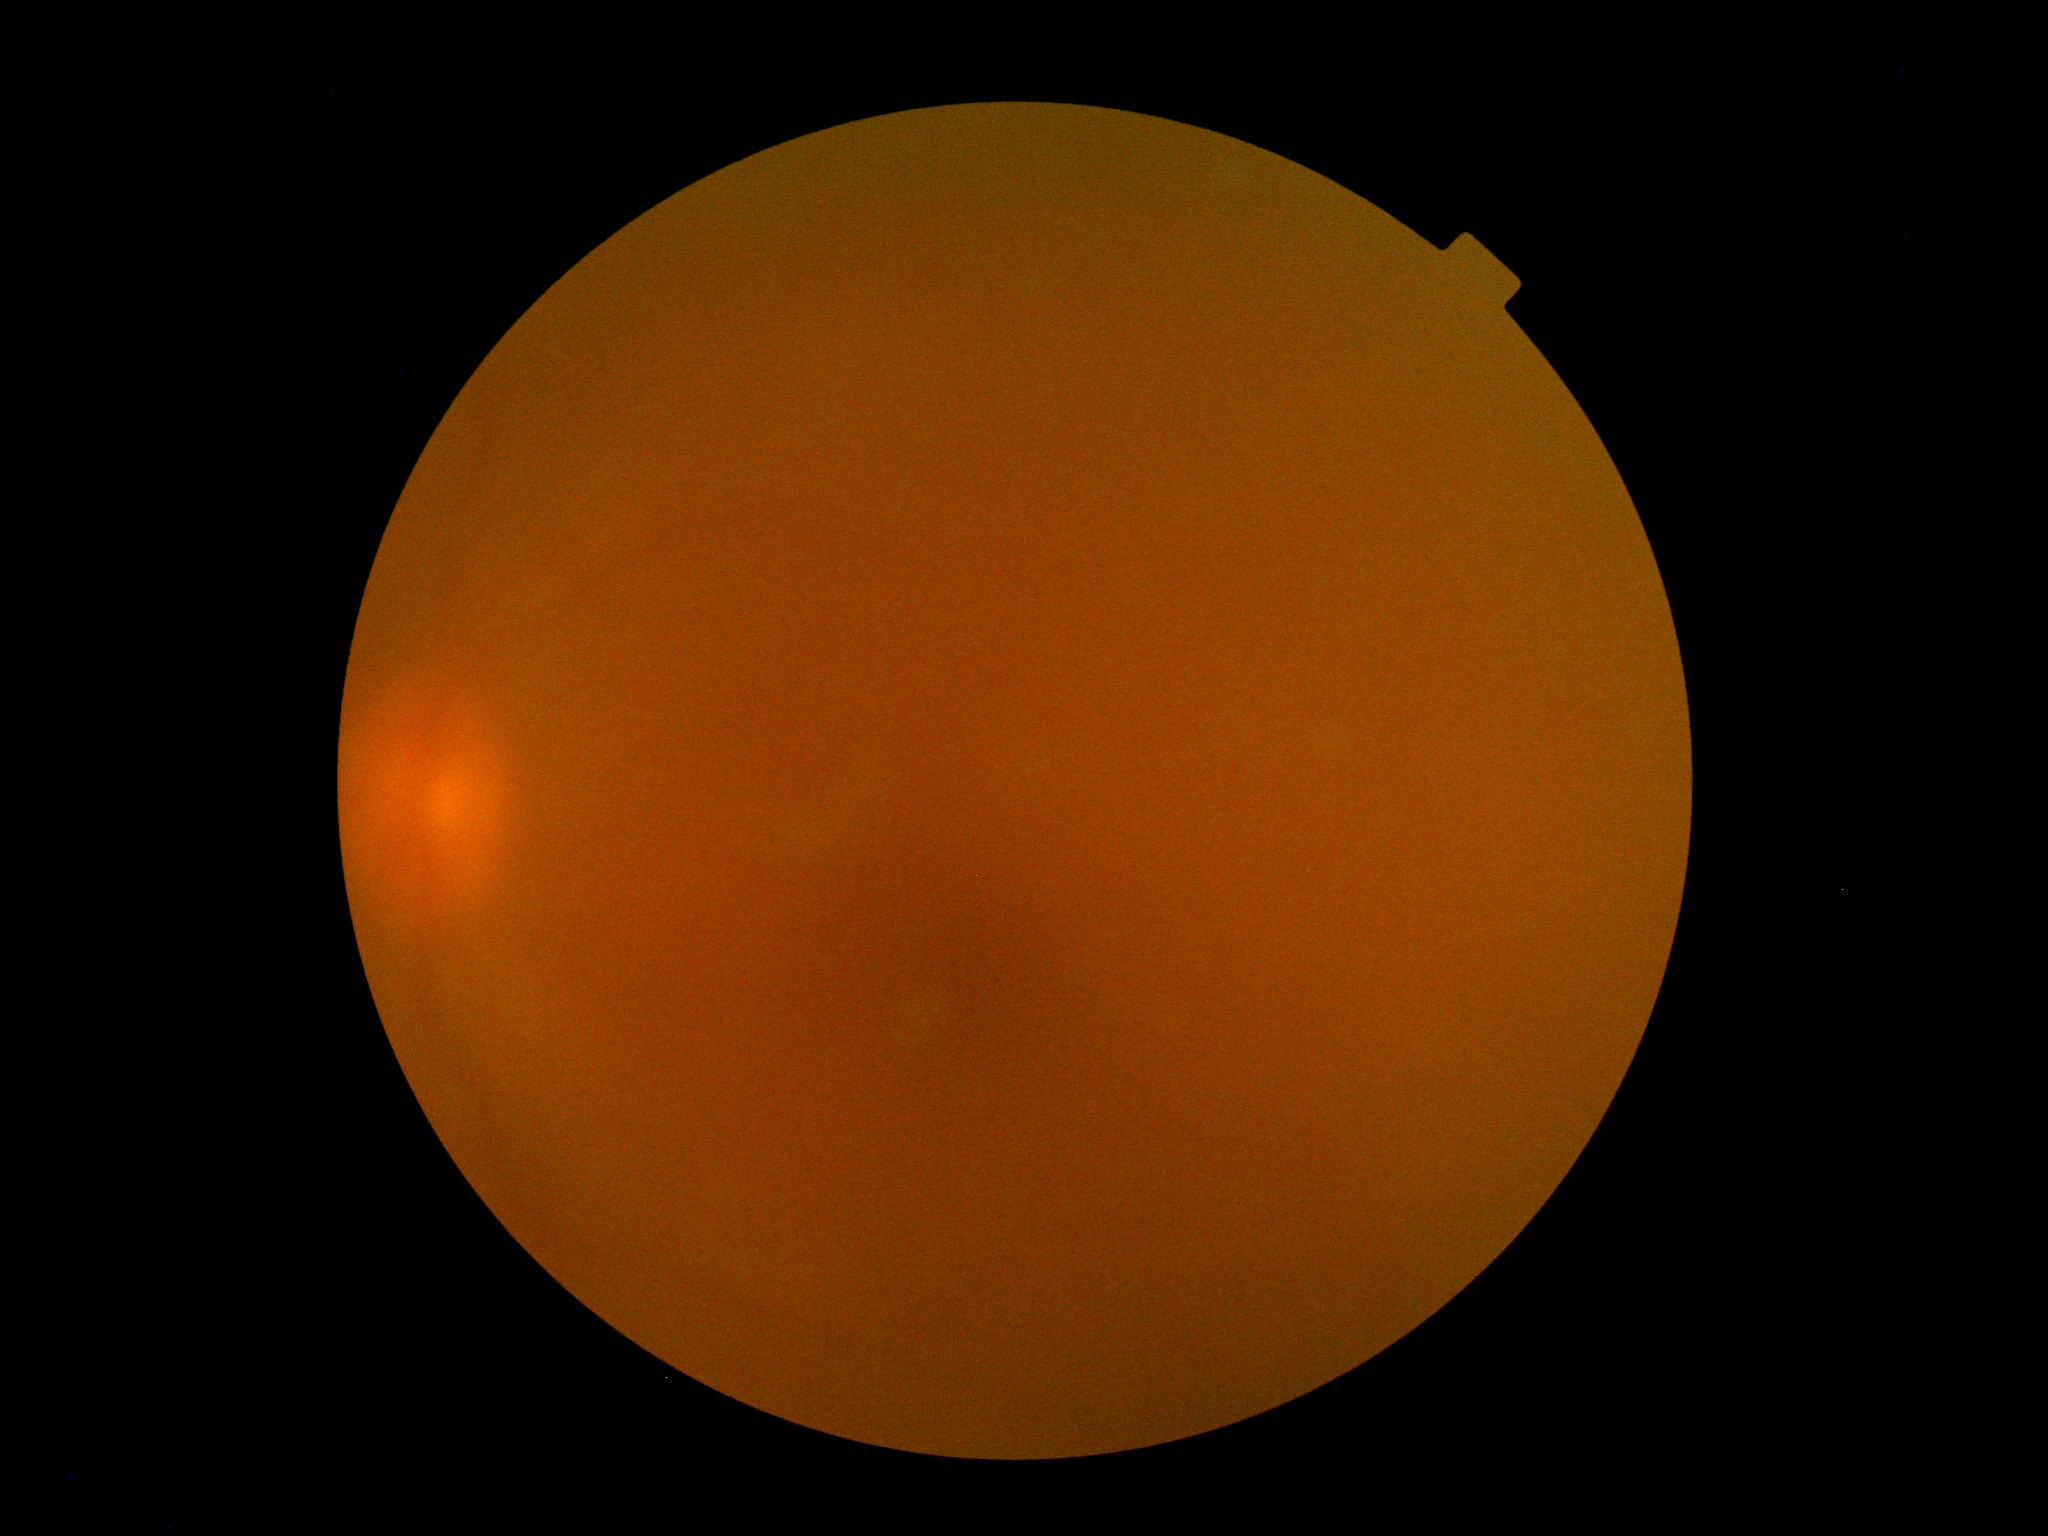
Diabetic retinopathy (DR) is ungradable due to poor image quality.